CFP, diabetic retinopathy graded by the modified Davis classification, 45 degree fundus photograph, NIDEK AFC-230 fundus camera, 848x848px.
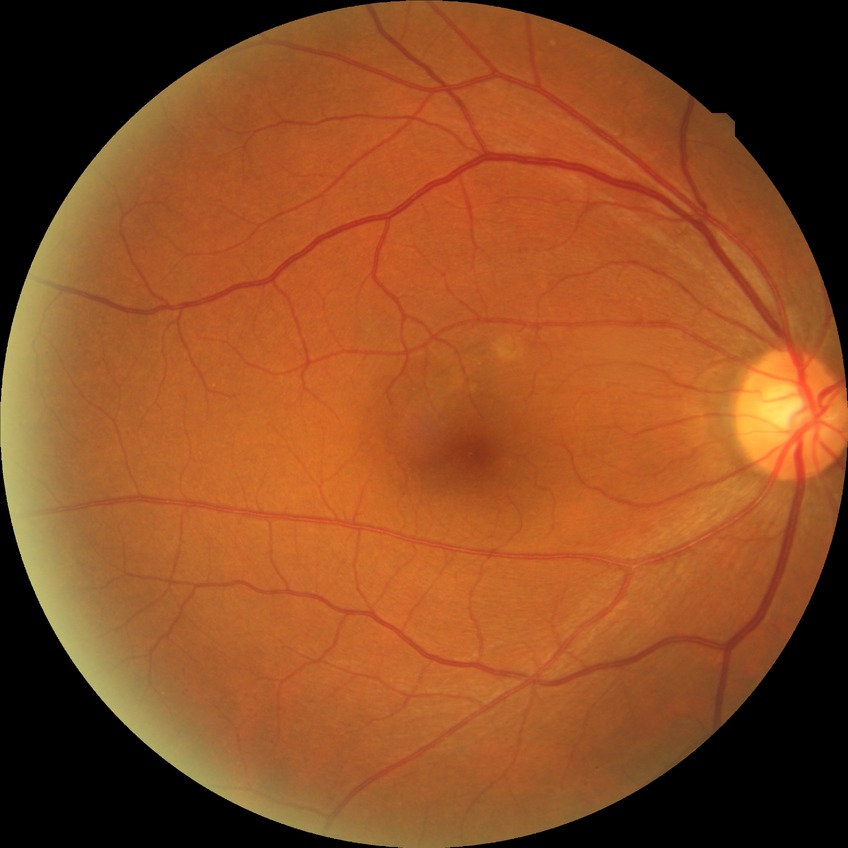
DR stage: NDR.